Color fundus photograph:
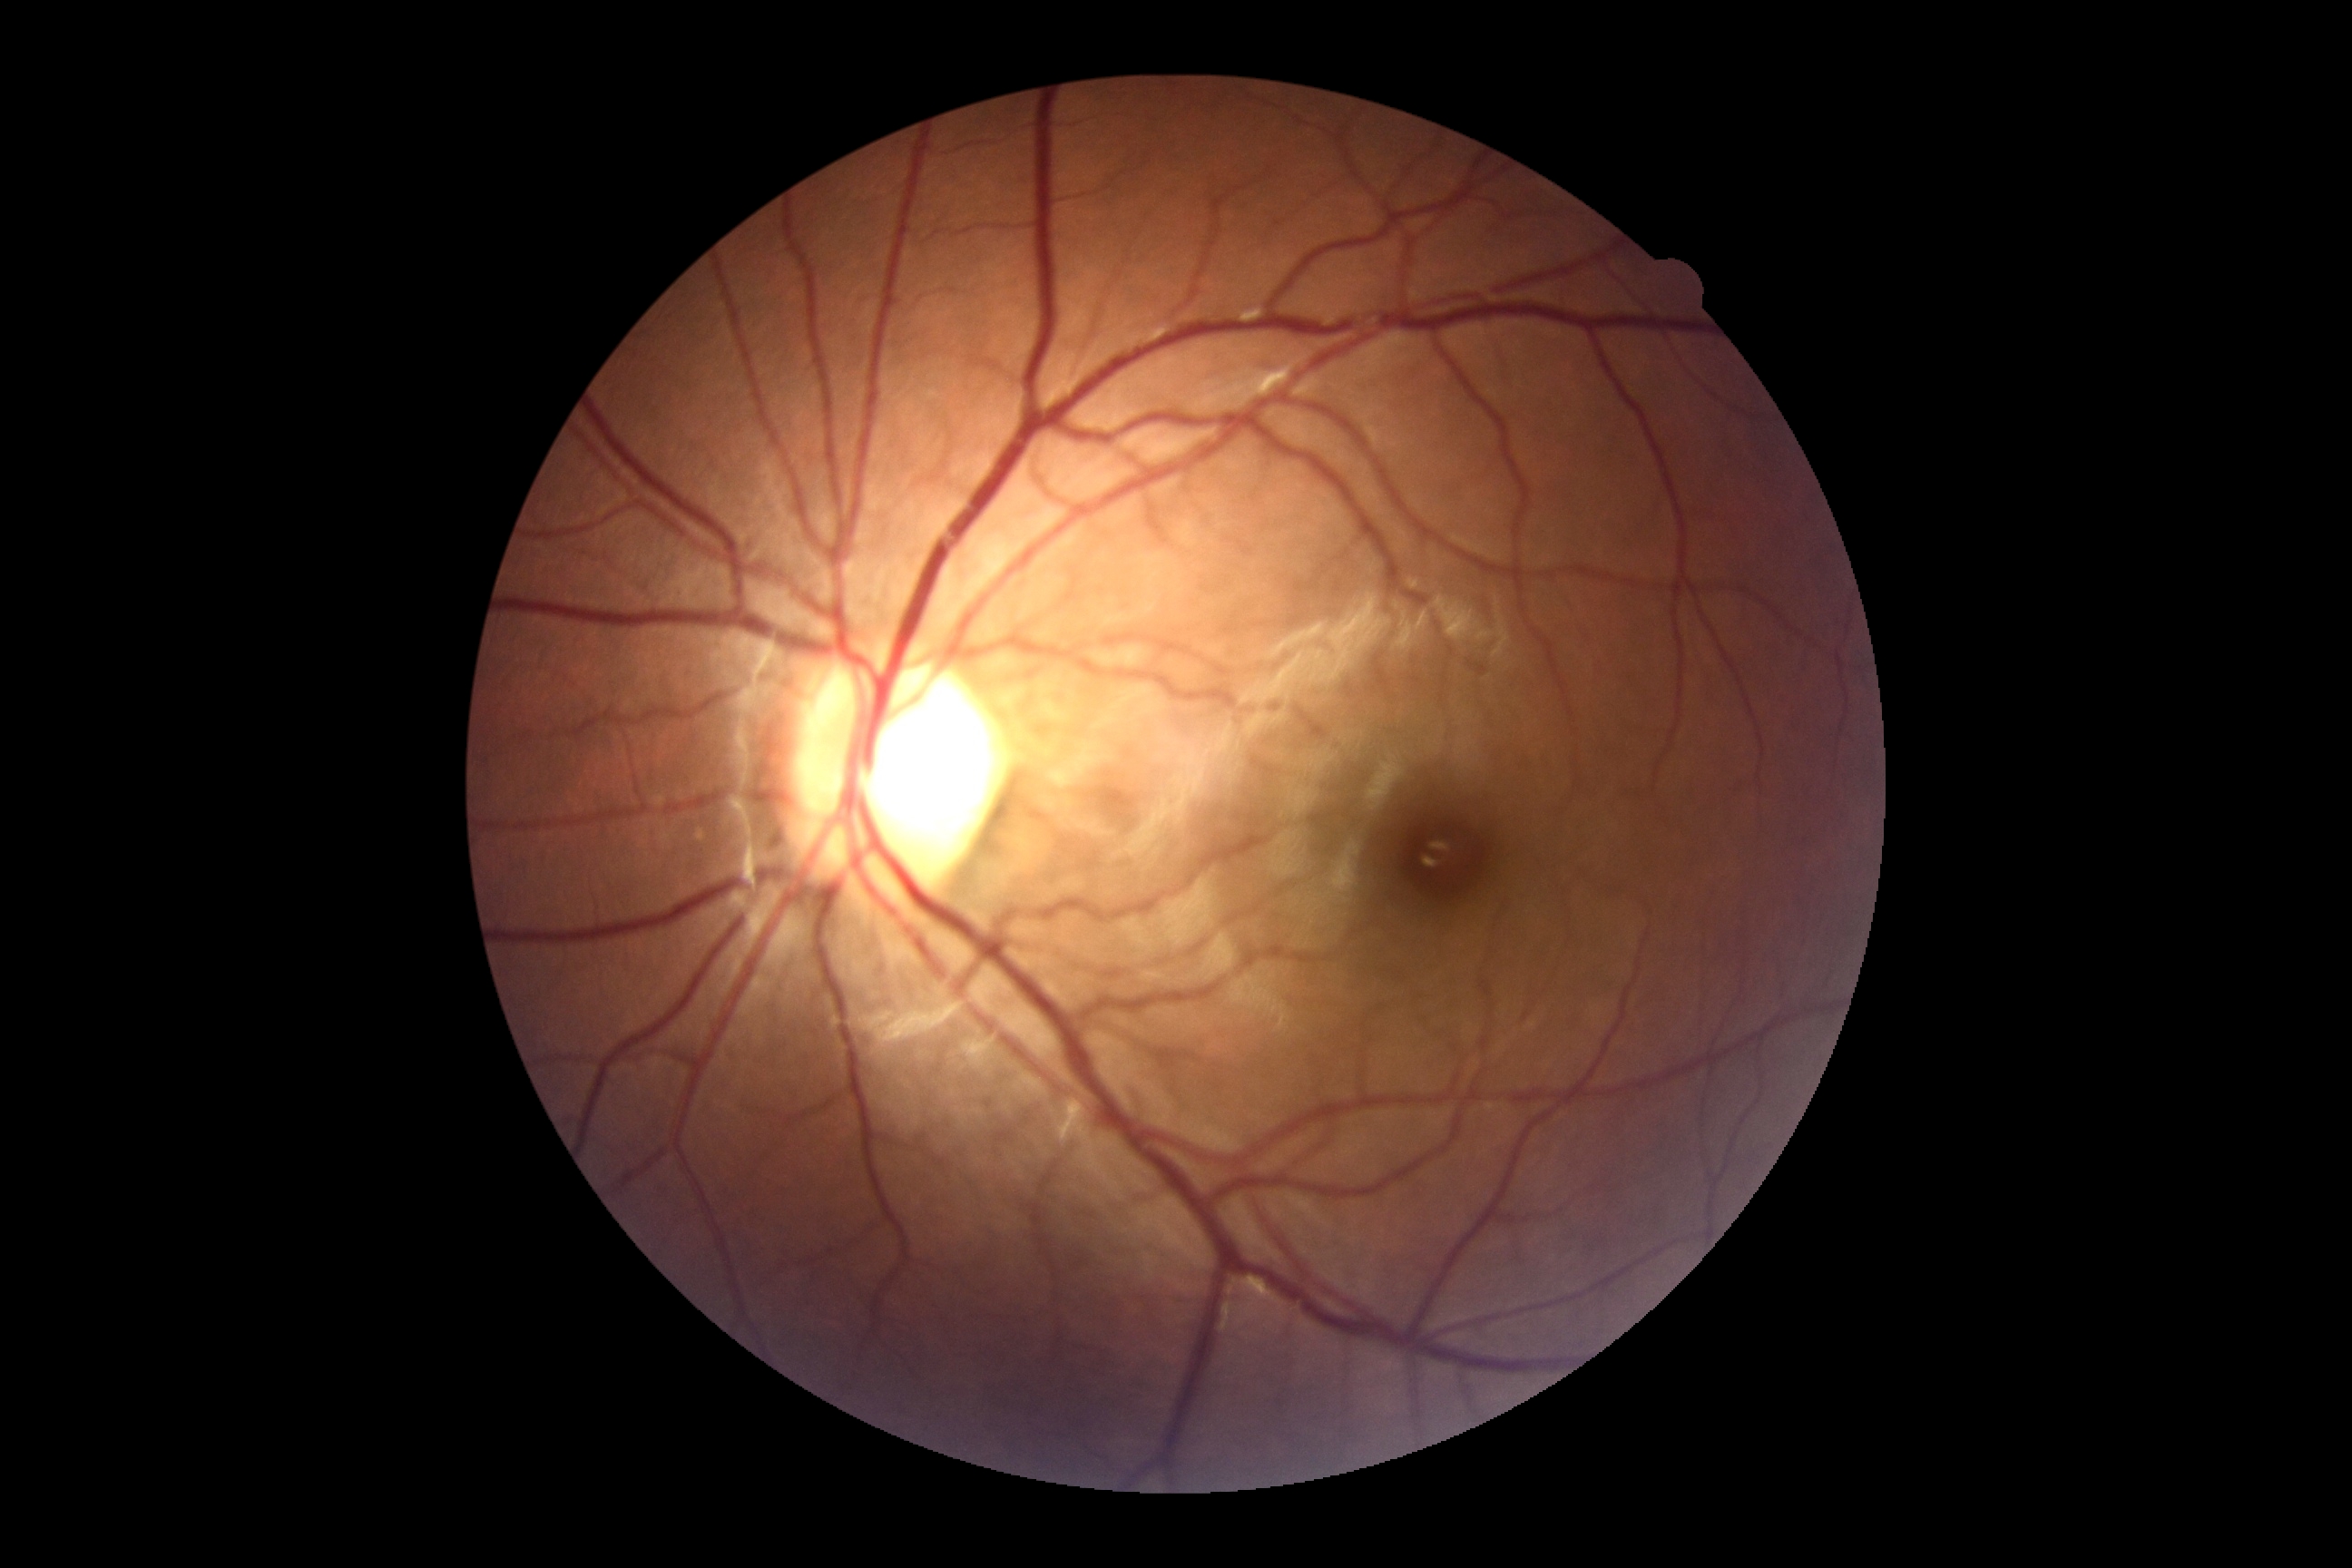
No apparent diabetic retinopathy.
Retinopathy grade is no apparent retinopathy (0) — no visible signs of diabetic retinopathy.